Fundus photo: 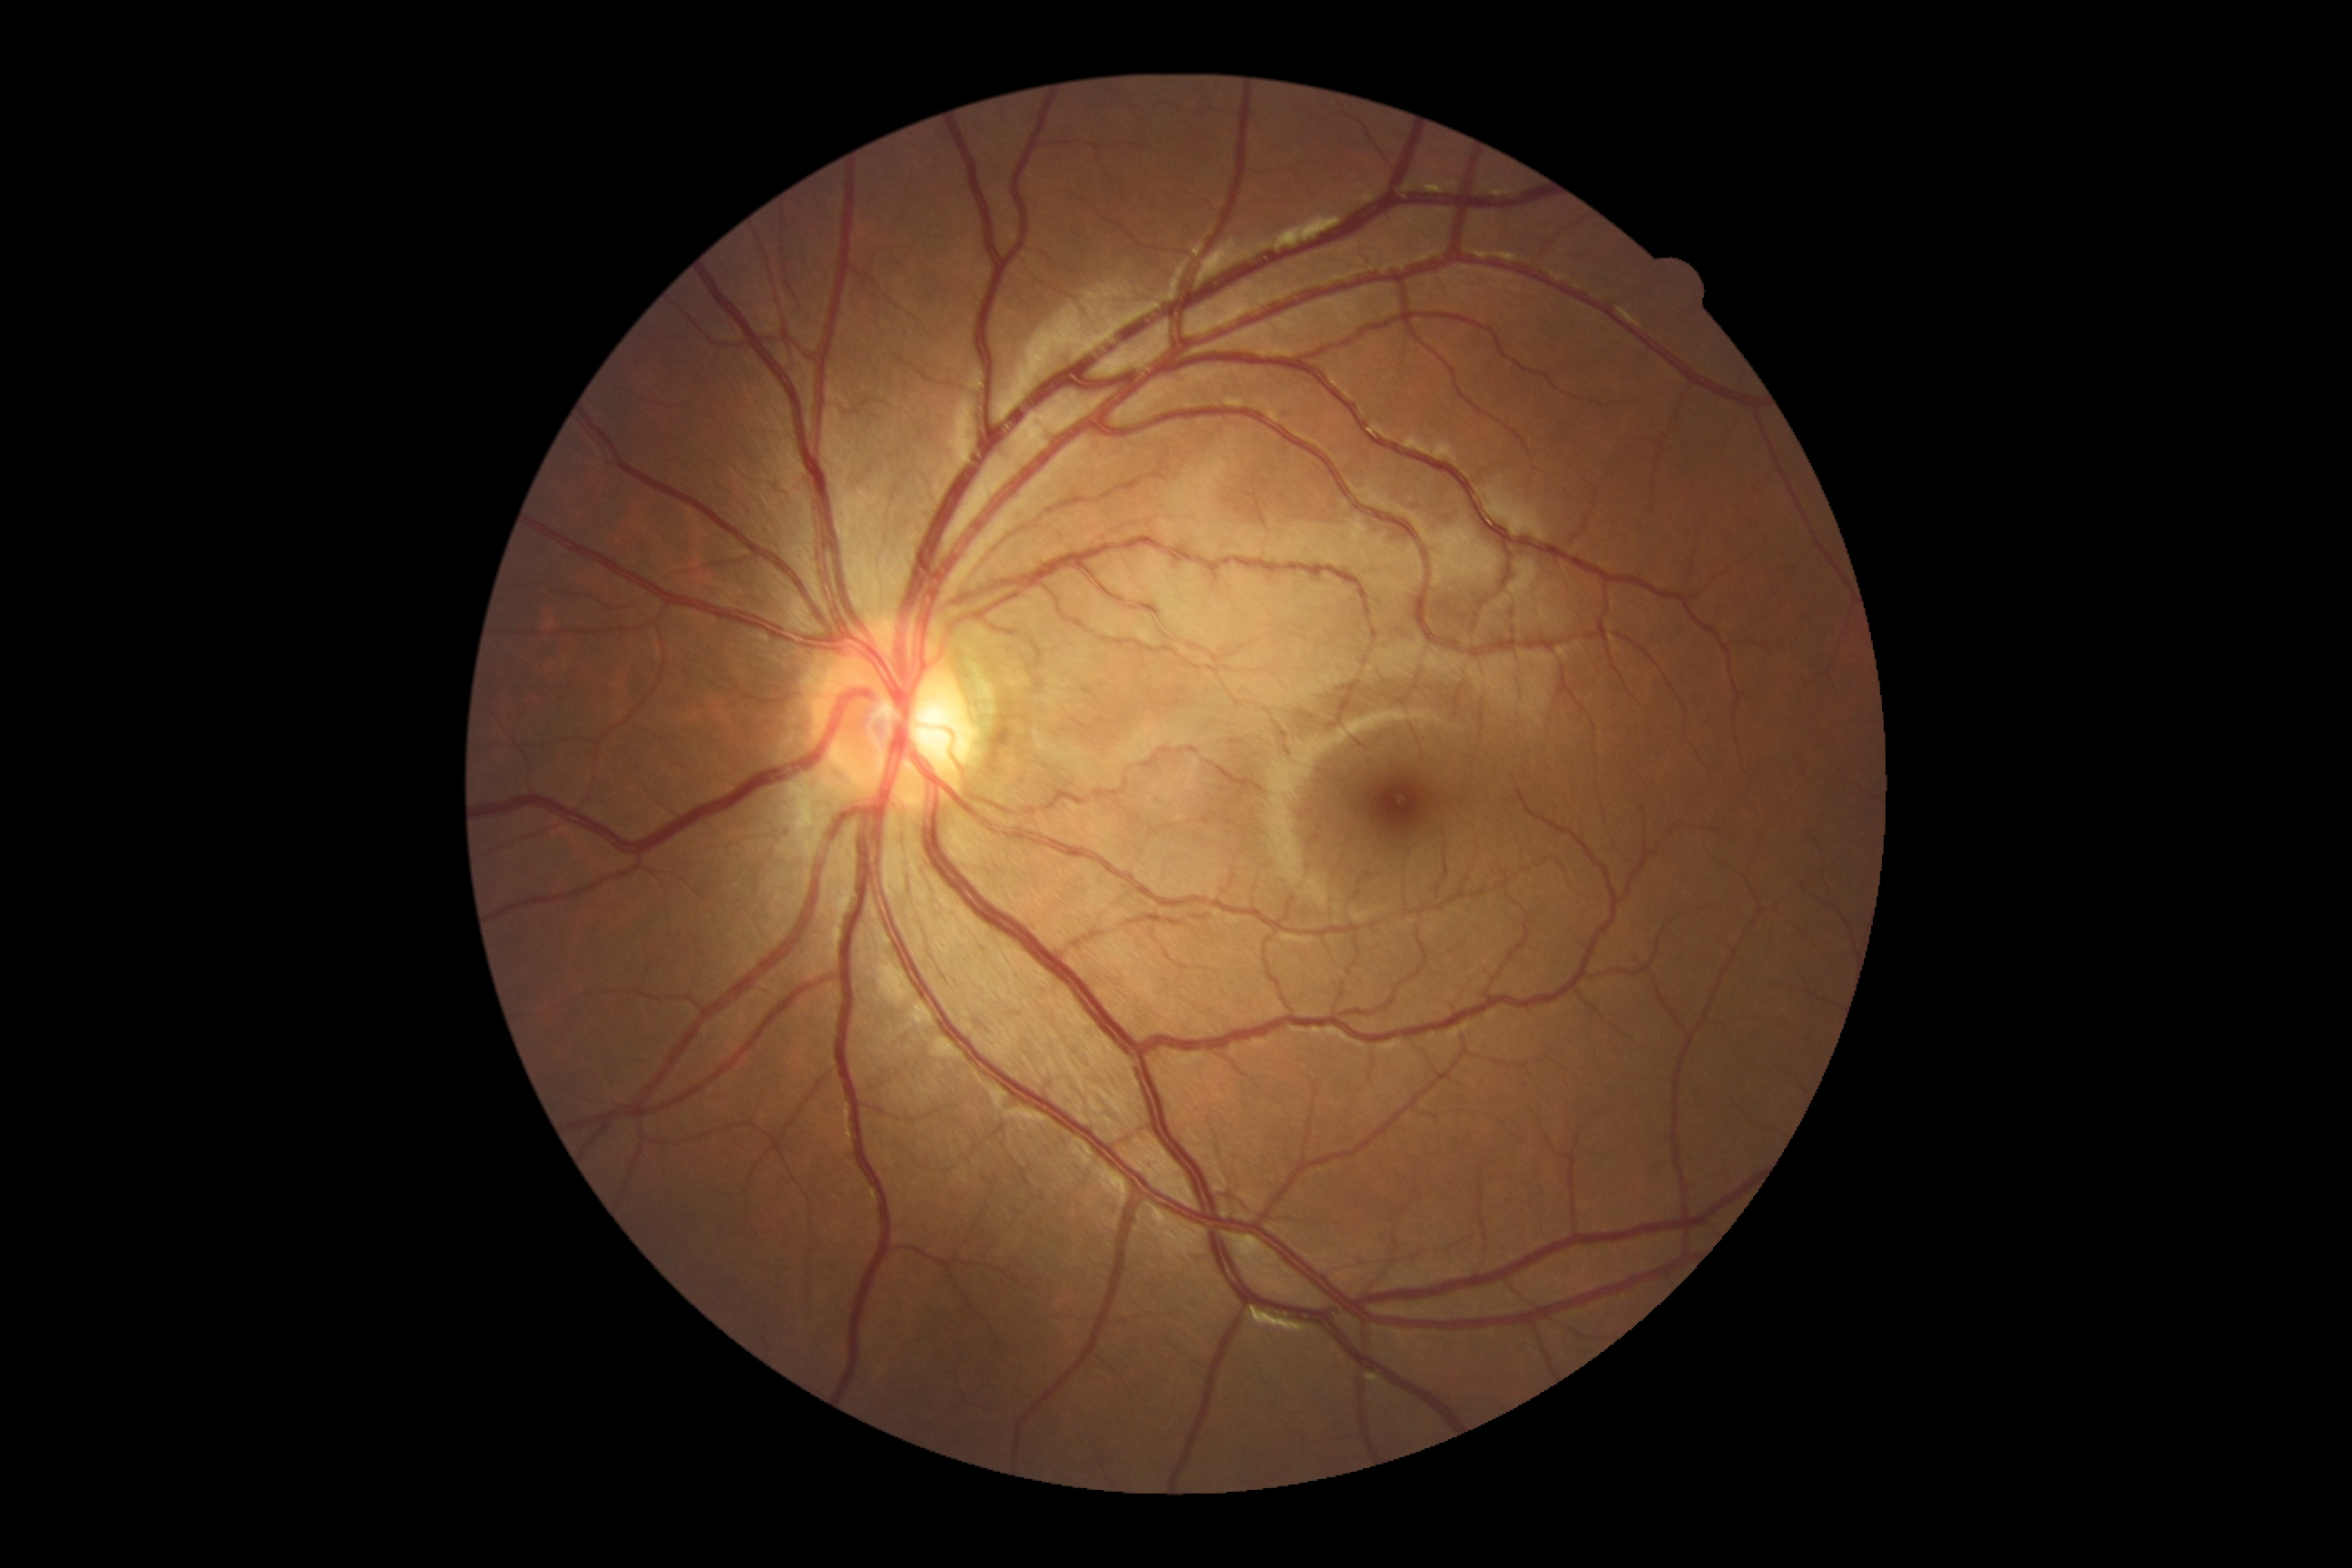

{
  "dr_impression": "no DR findings",
  "dr_grade": "0/4"
}